Phoenix ICON wide-field infant fundus image — 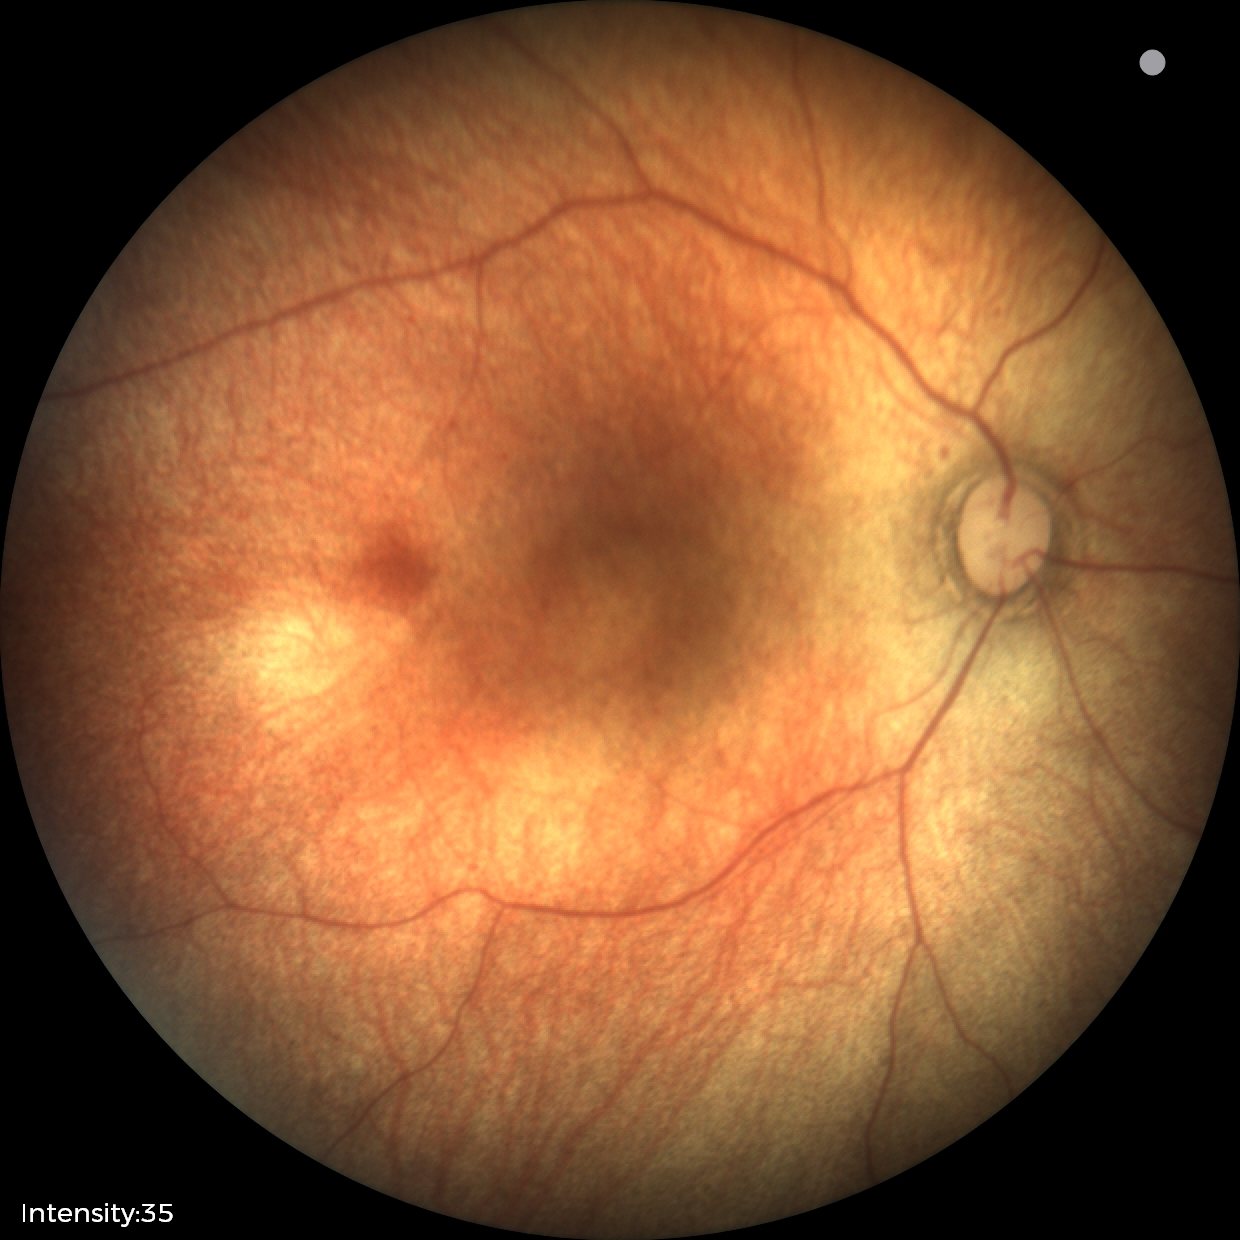

Finding: physiological.